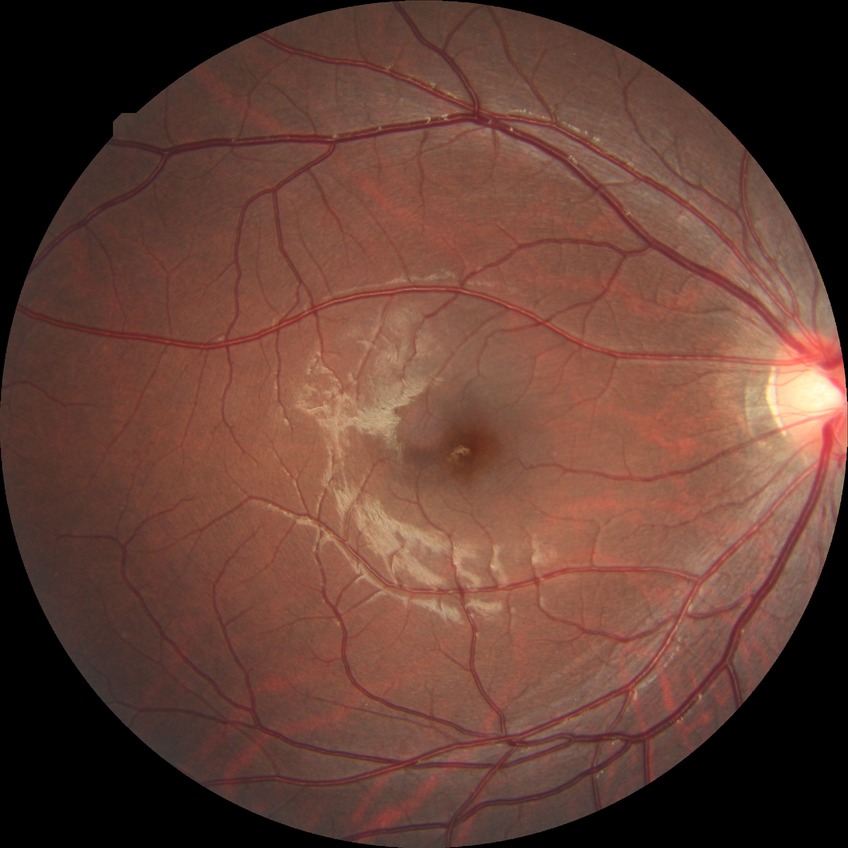 Diabetic retinopathy grade is no diabetic retinopathy.